Modified Davis grading
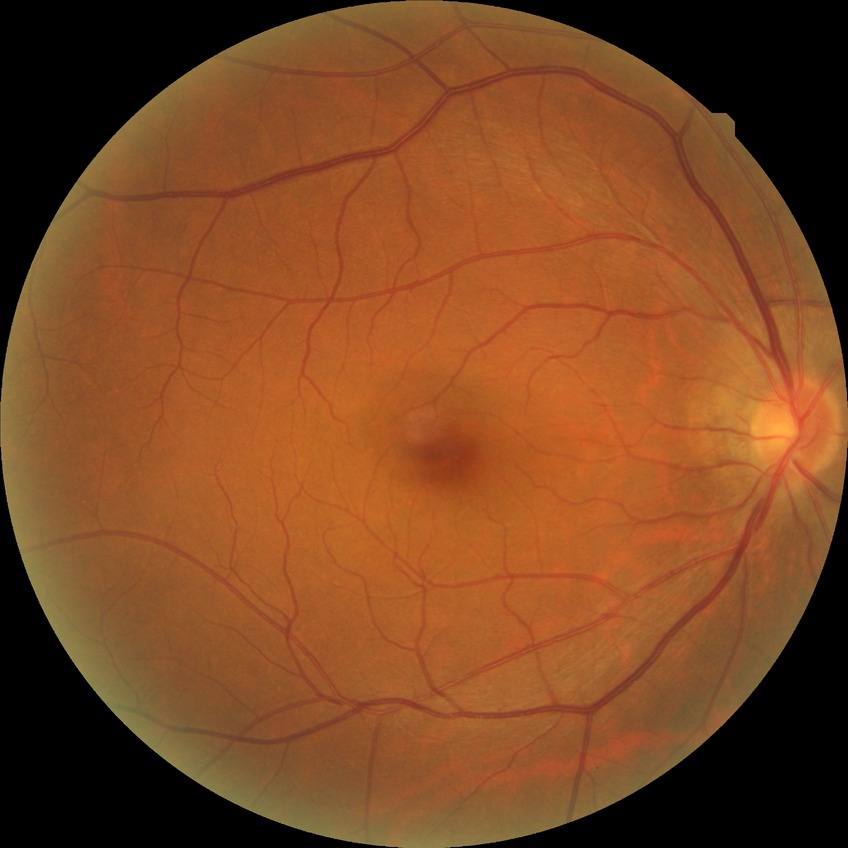 Diabetic retinopathy (DR) is NDR (no diabetic retinopathy).